50-degree field of view.
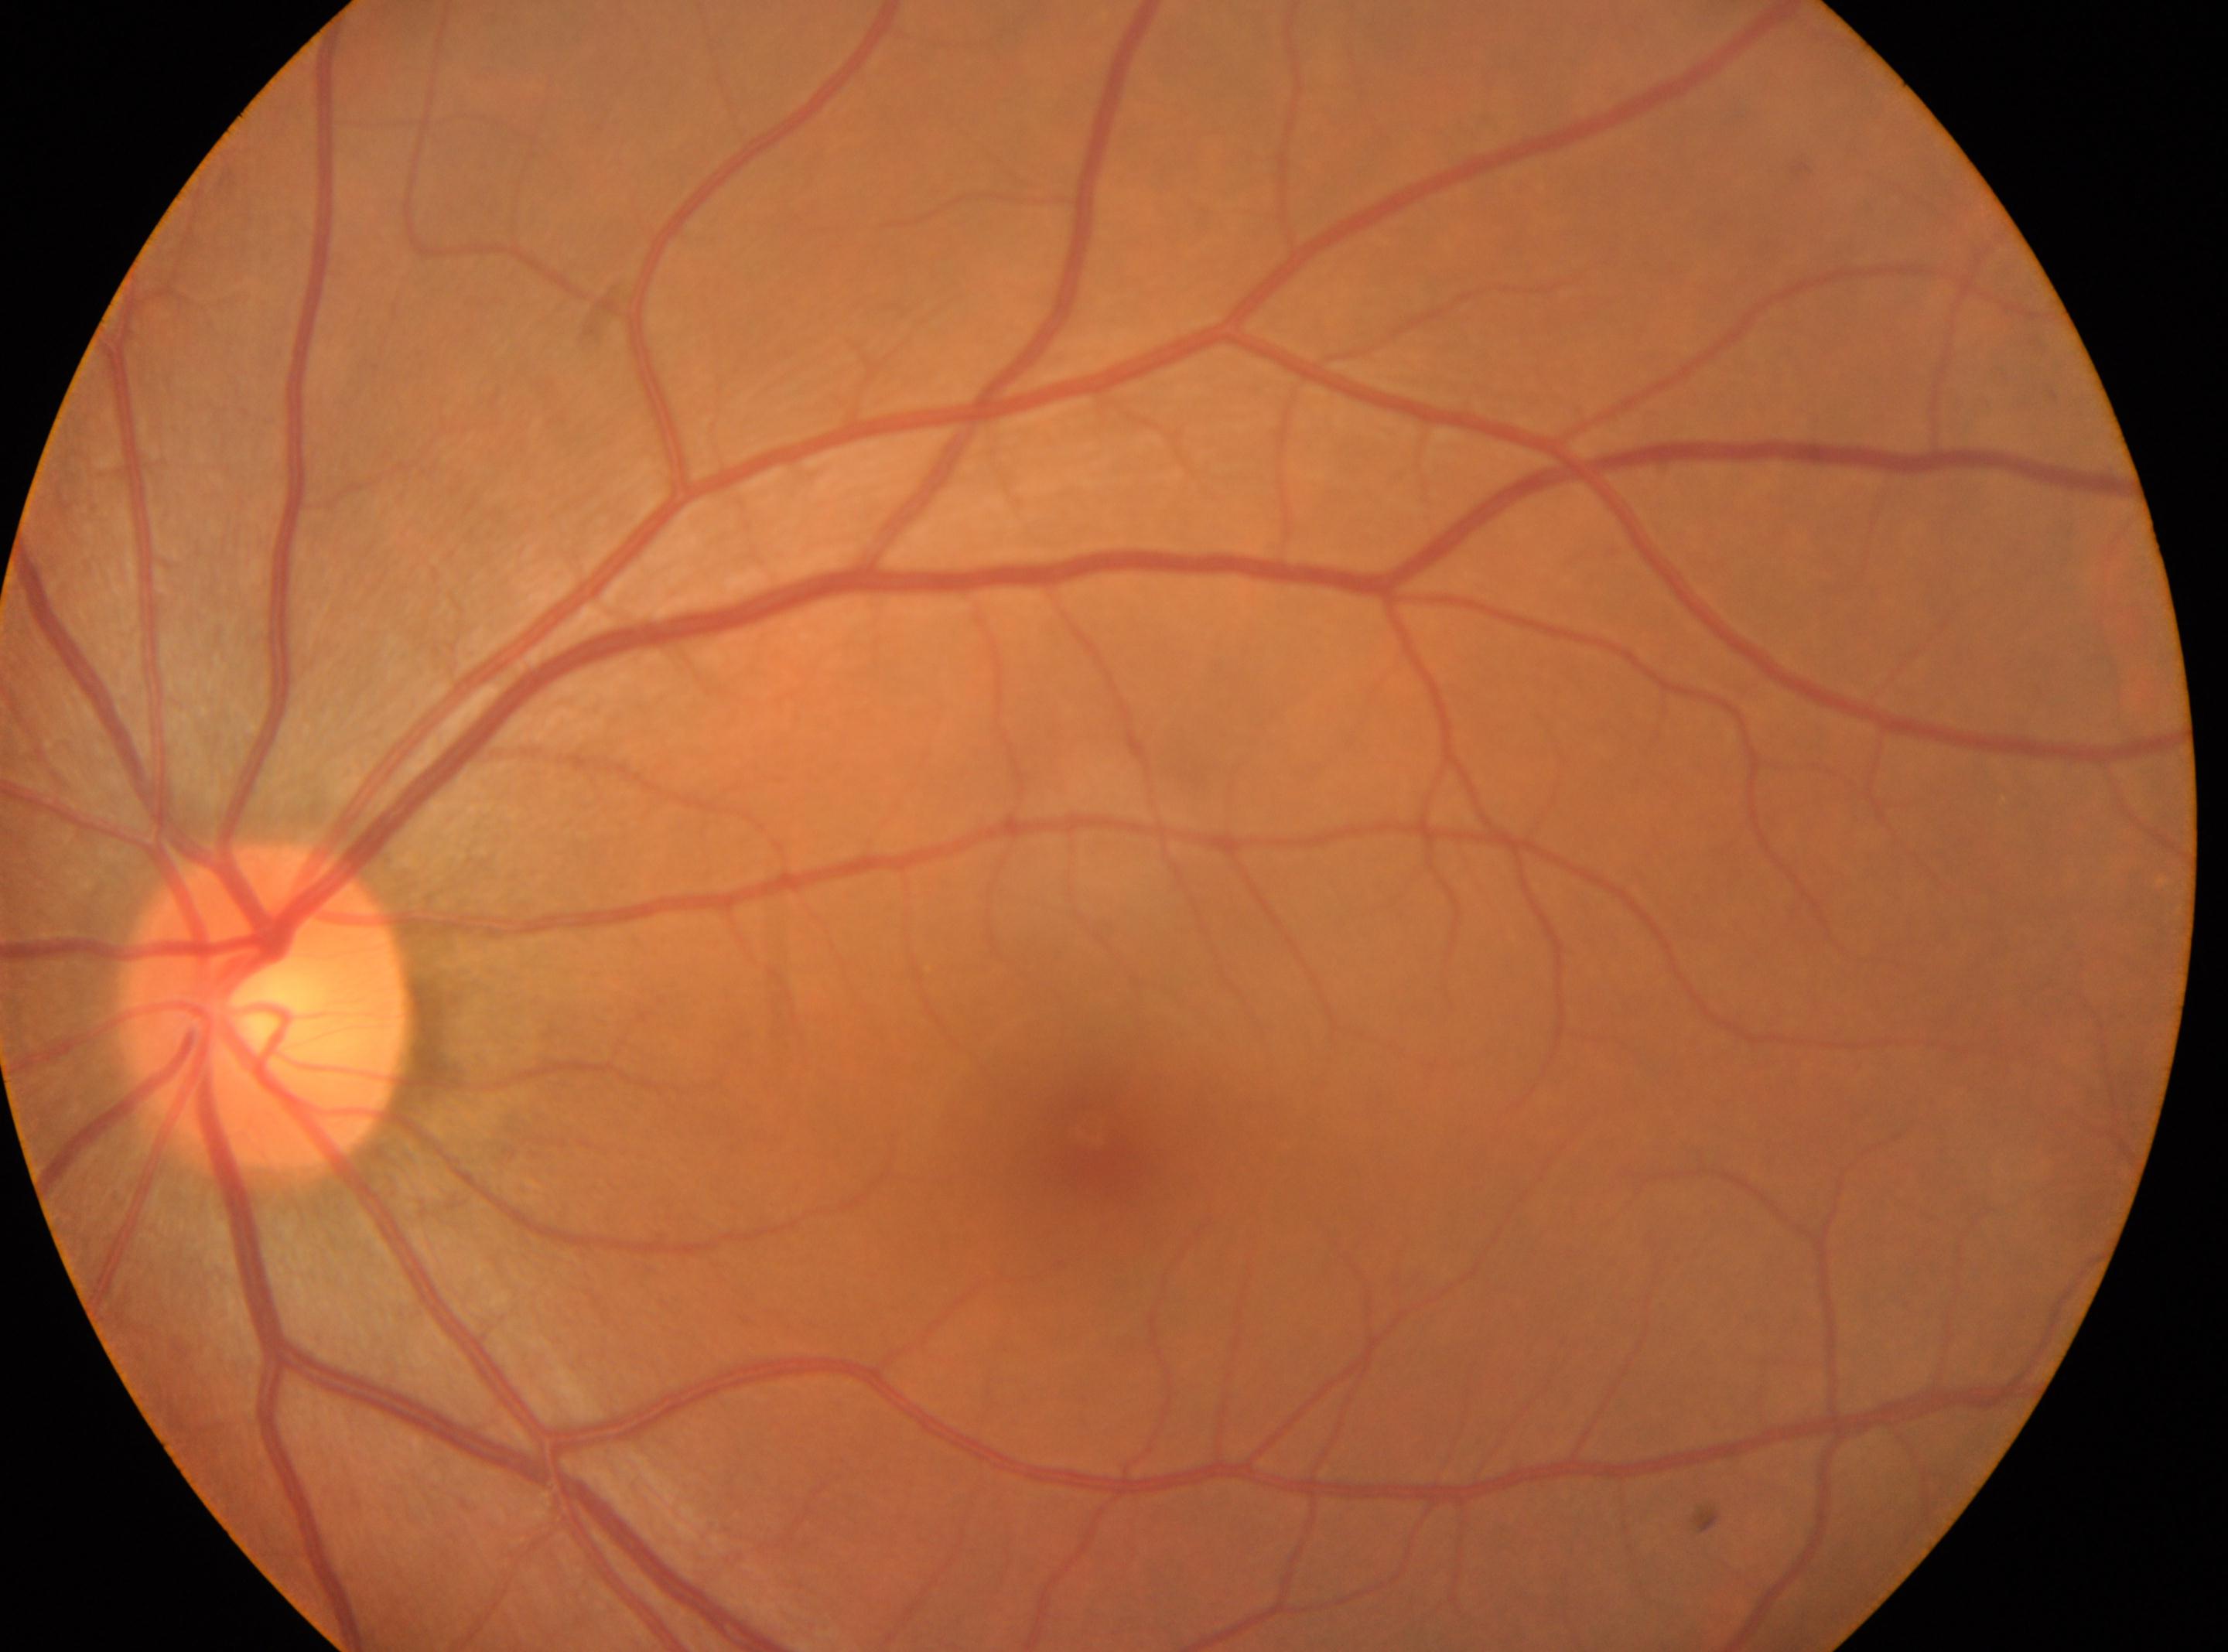
The optic disc is at (x: 267, y: 1005). Imaged eye: left. Diabetic retinopathy is 0 — no visible signs of diabetic retinopathy. Fovea located at (x: 1092, y: 1131).